848 by 848 pixels. Camera: NIDEK AFC-230:
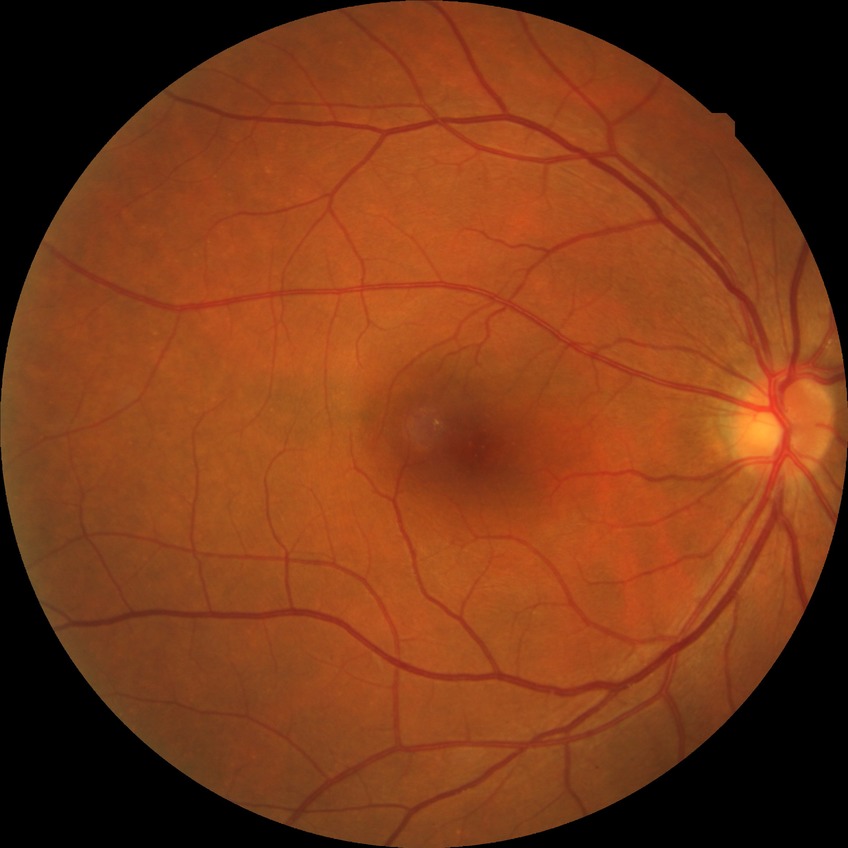

- retinopathy stage — no diabetic retinopathy